2048 x 1536 pixels · CFP:
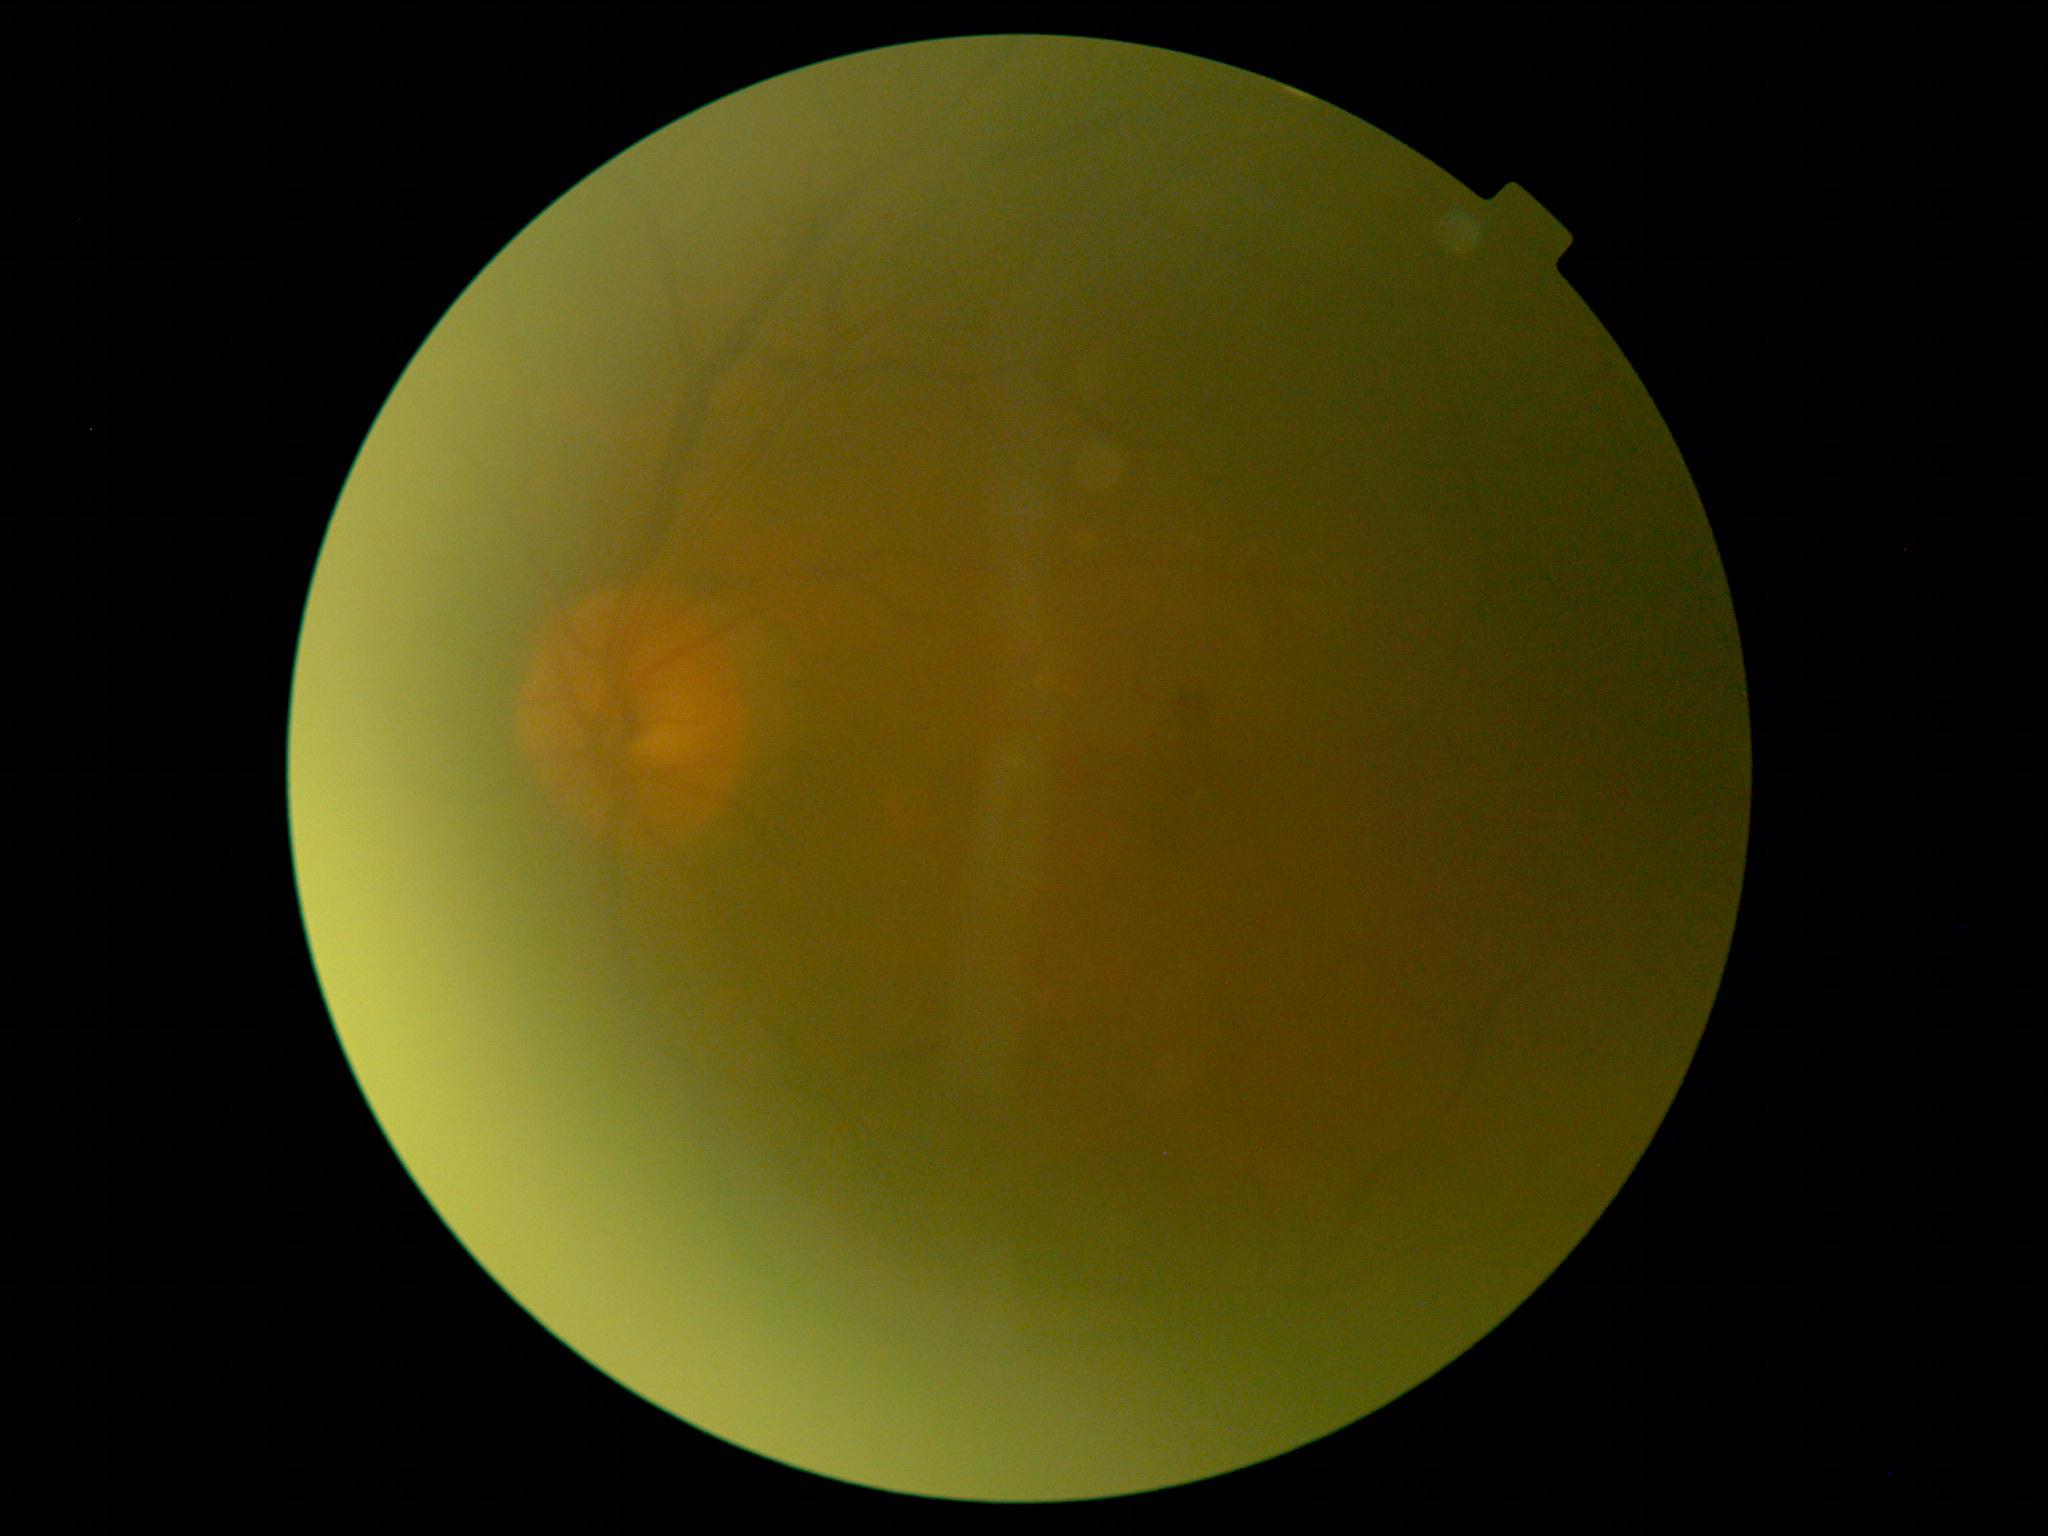

Diabetic retinopathy is moderate non-proliferative diabetic retinopathy (grade 2).
DR class: non-proliferative diabetic retinopathy.